640x480px; wide-field fundus photograph from neonatal ROP screening
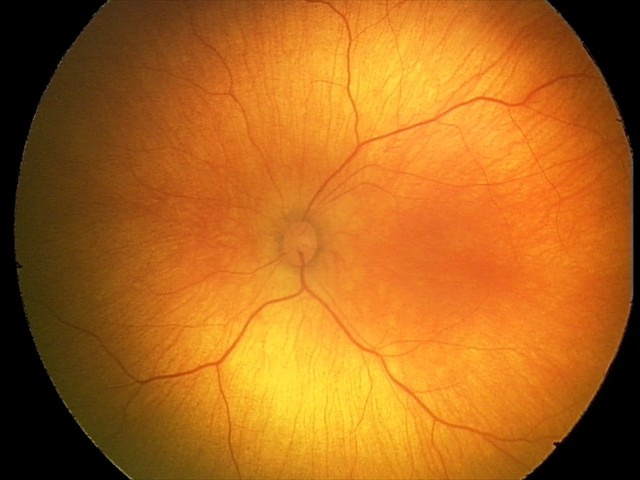
Screening examination with no abnormal retinal findings.